Phoenix ICON, 100° FOV. 1240x1240px. Infant wide-field fundus photograph.
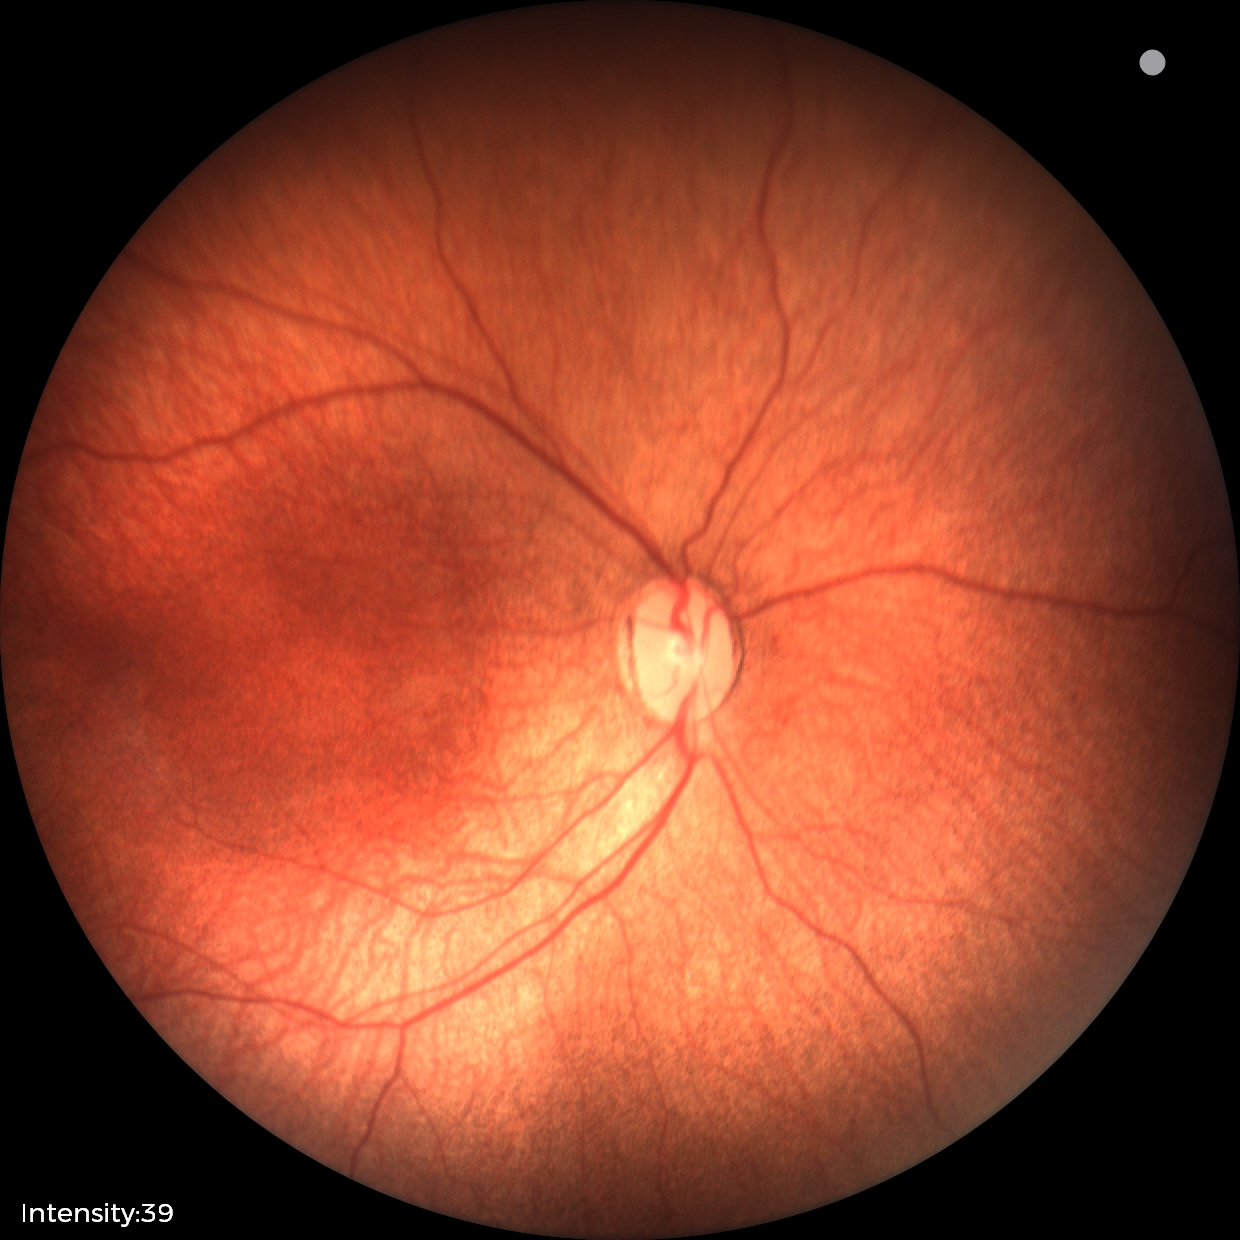 Plus disease absent.
Screening examination consistent with status post ROP.